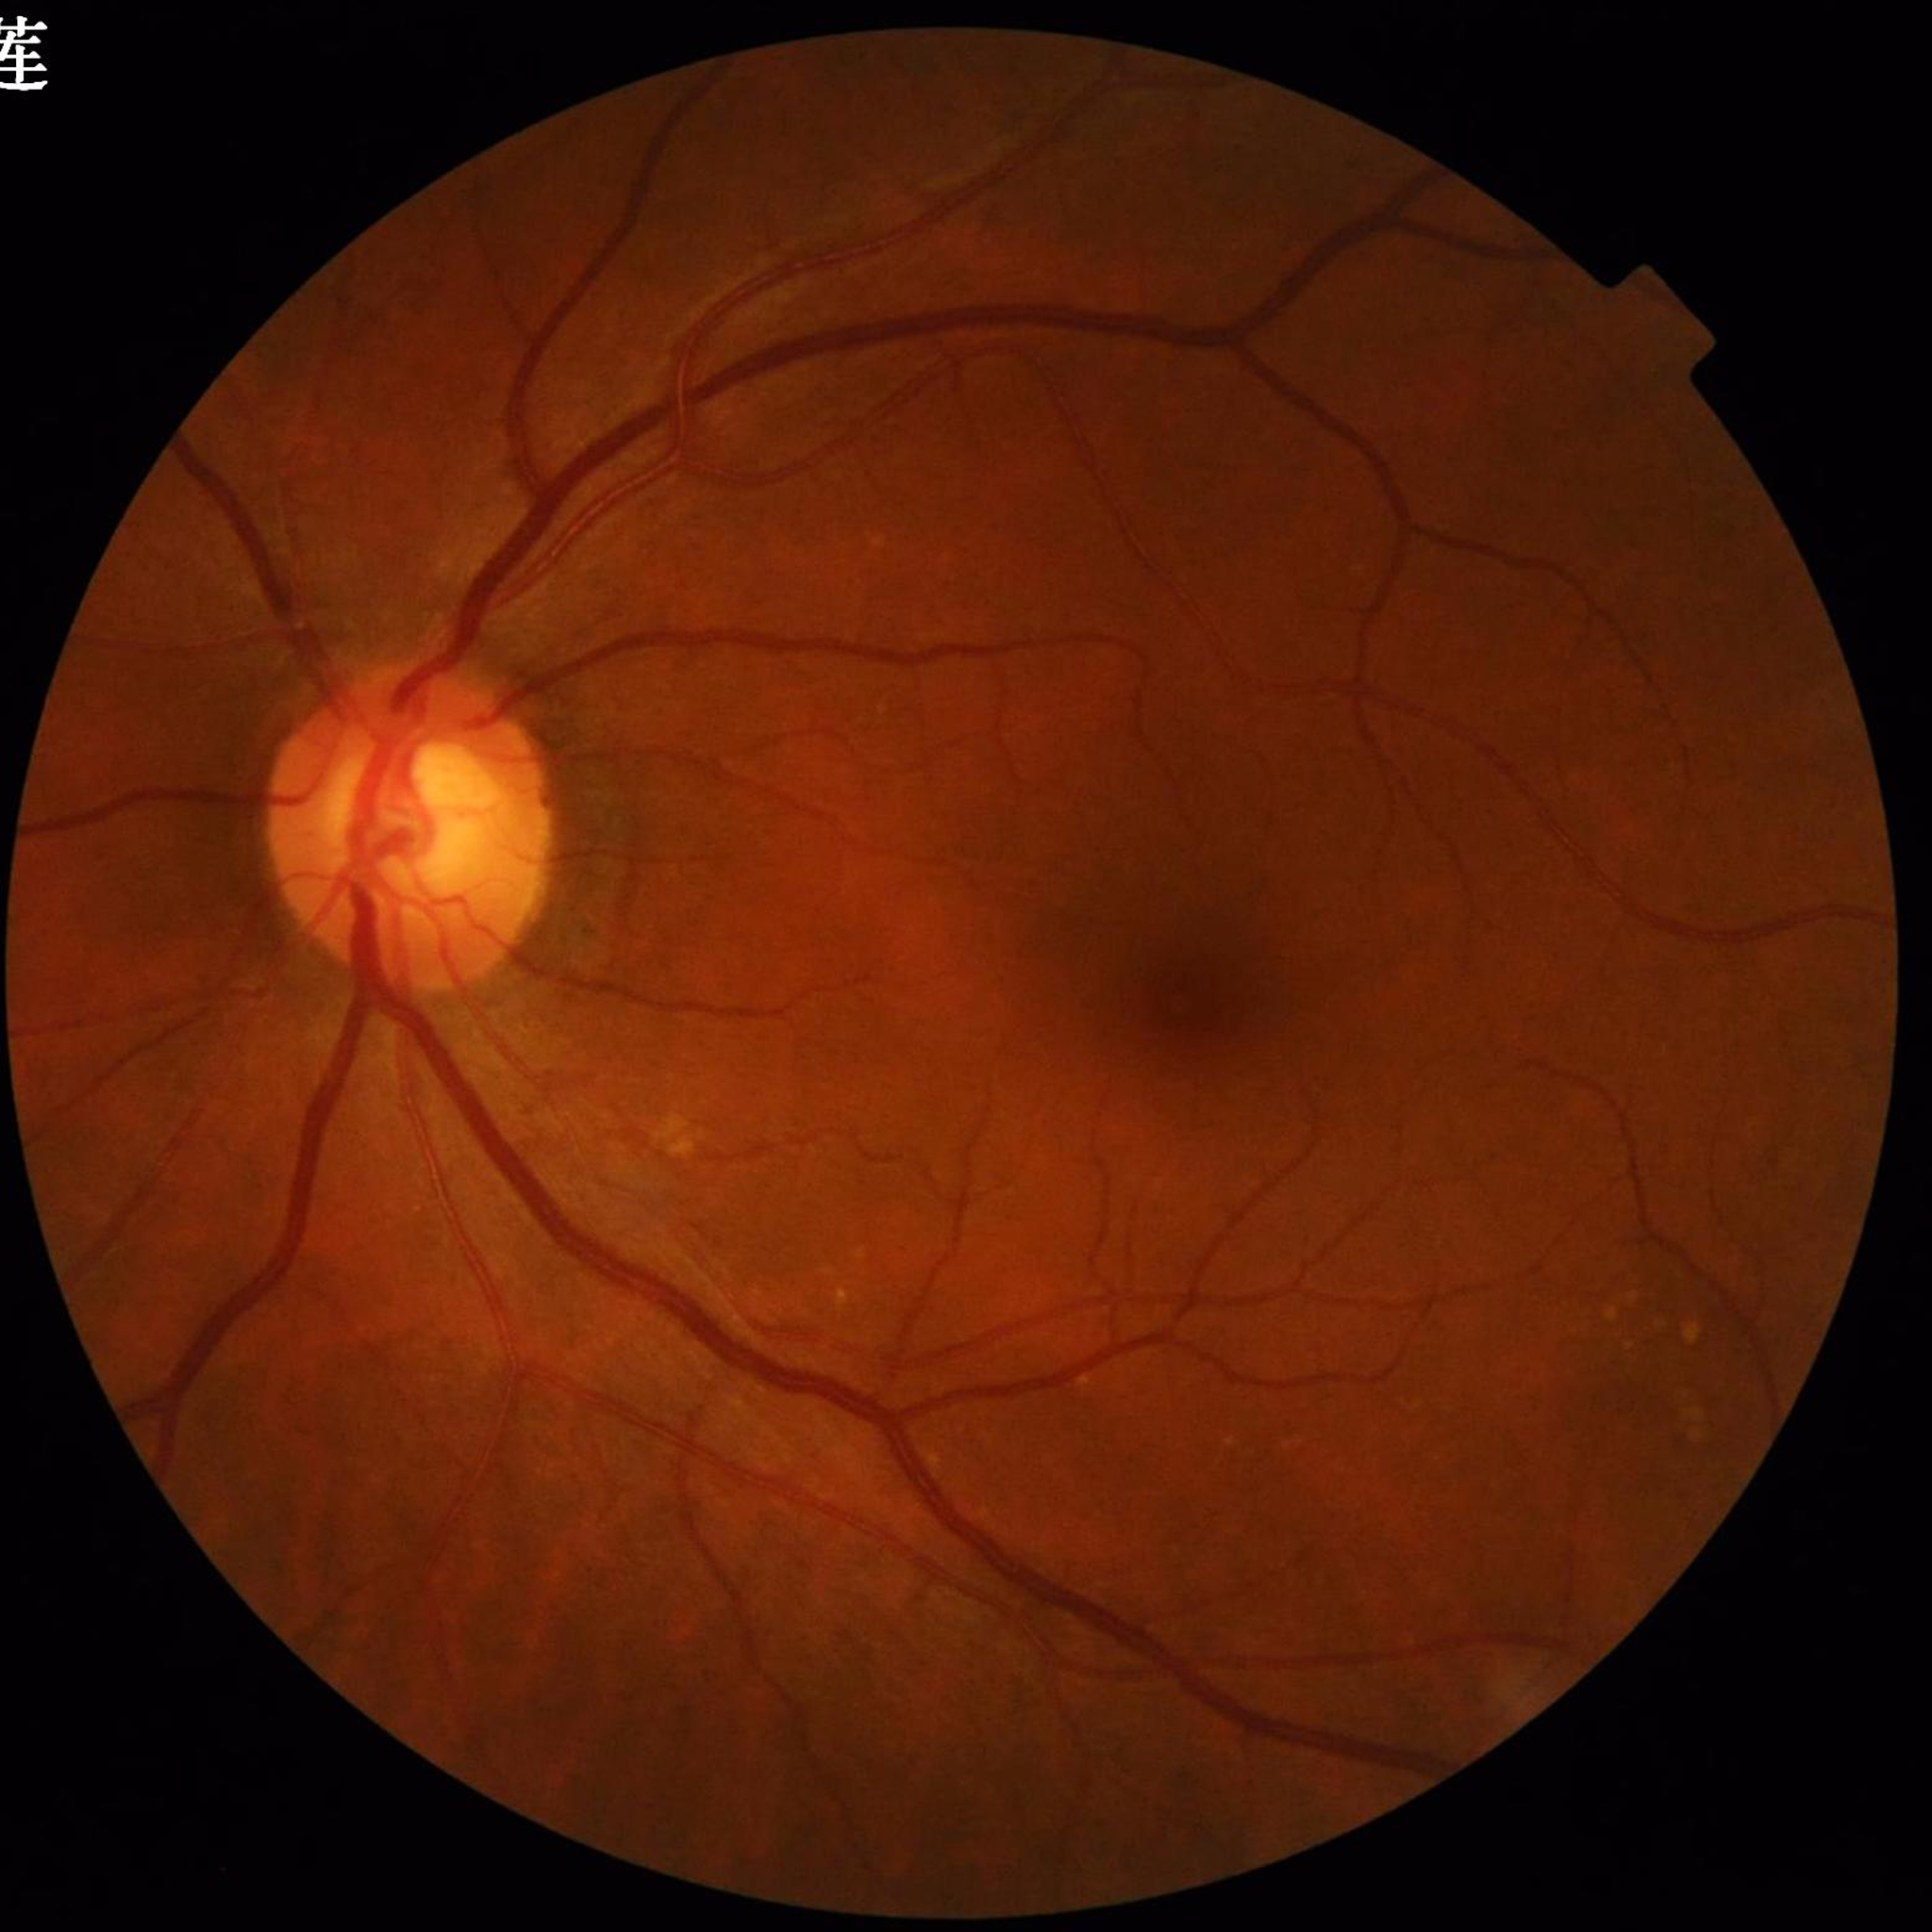

Diagnosis: age-related macular degeneration (AMD).